Phoenix ICON wide-field infant fundus image; 1240 by 1240 pixels:
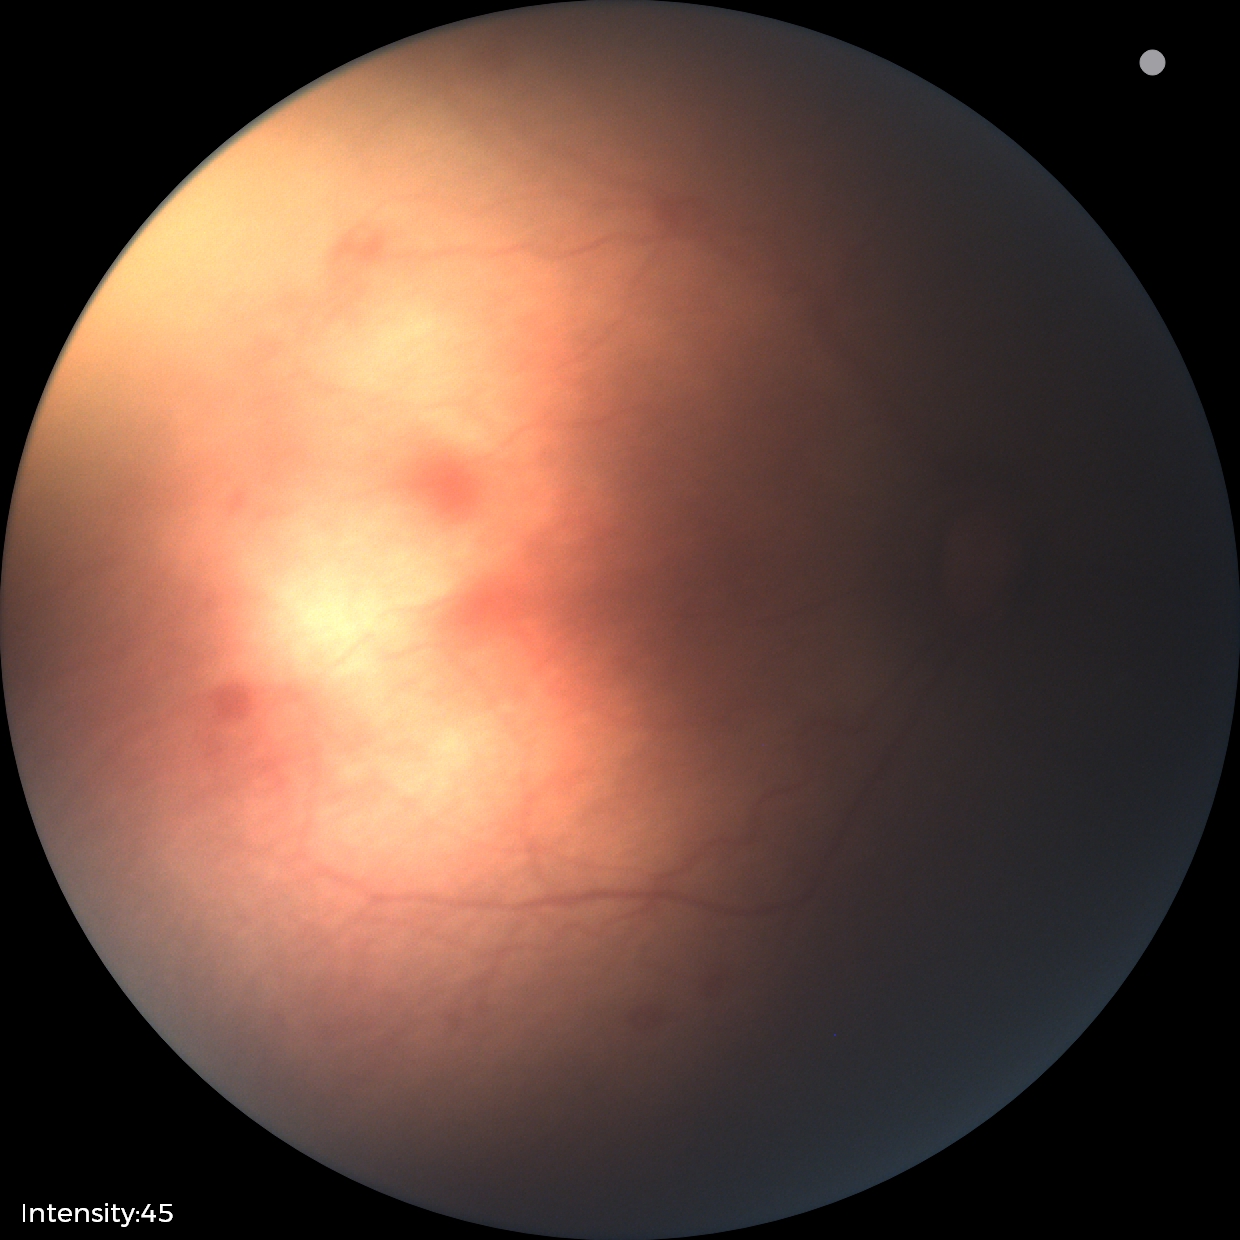

Series diagnosed as ROP stage 1 — demarcation line between vascular and avascular retina. Without plus disease.